Color fundus image, optic disc region crop.
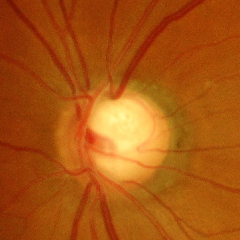 Advanced-stage glaucoma.